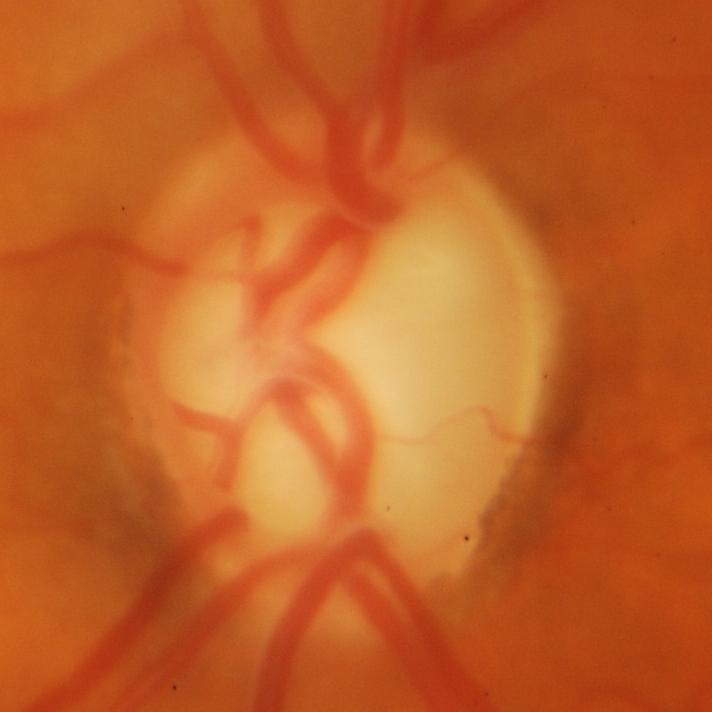
Diagnosis: glaucoma.